2352 x 1568 pixels · FOV: 45 degrees · color fundus image: 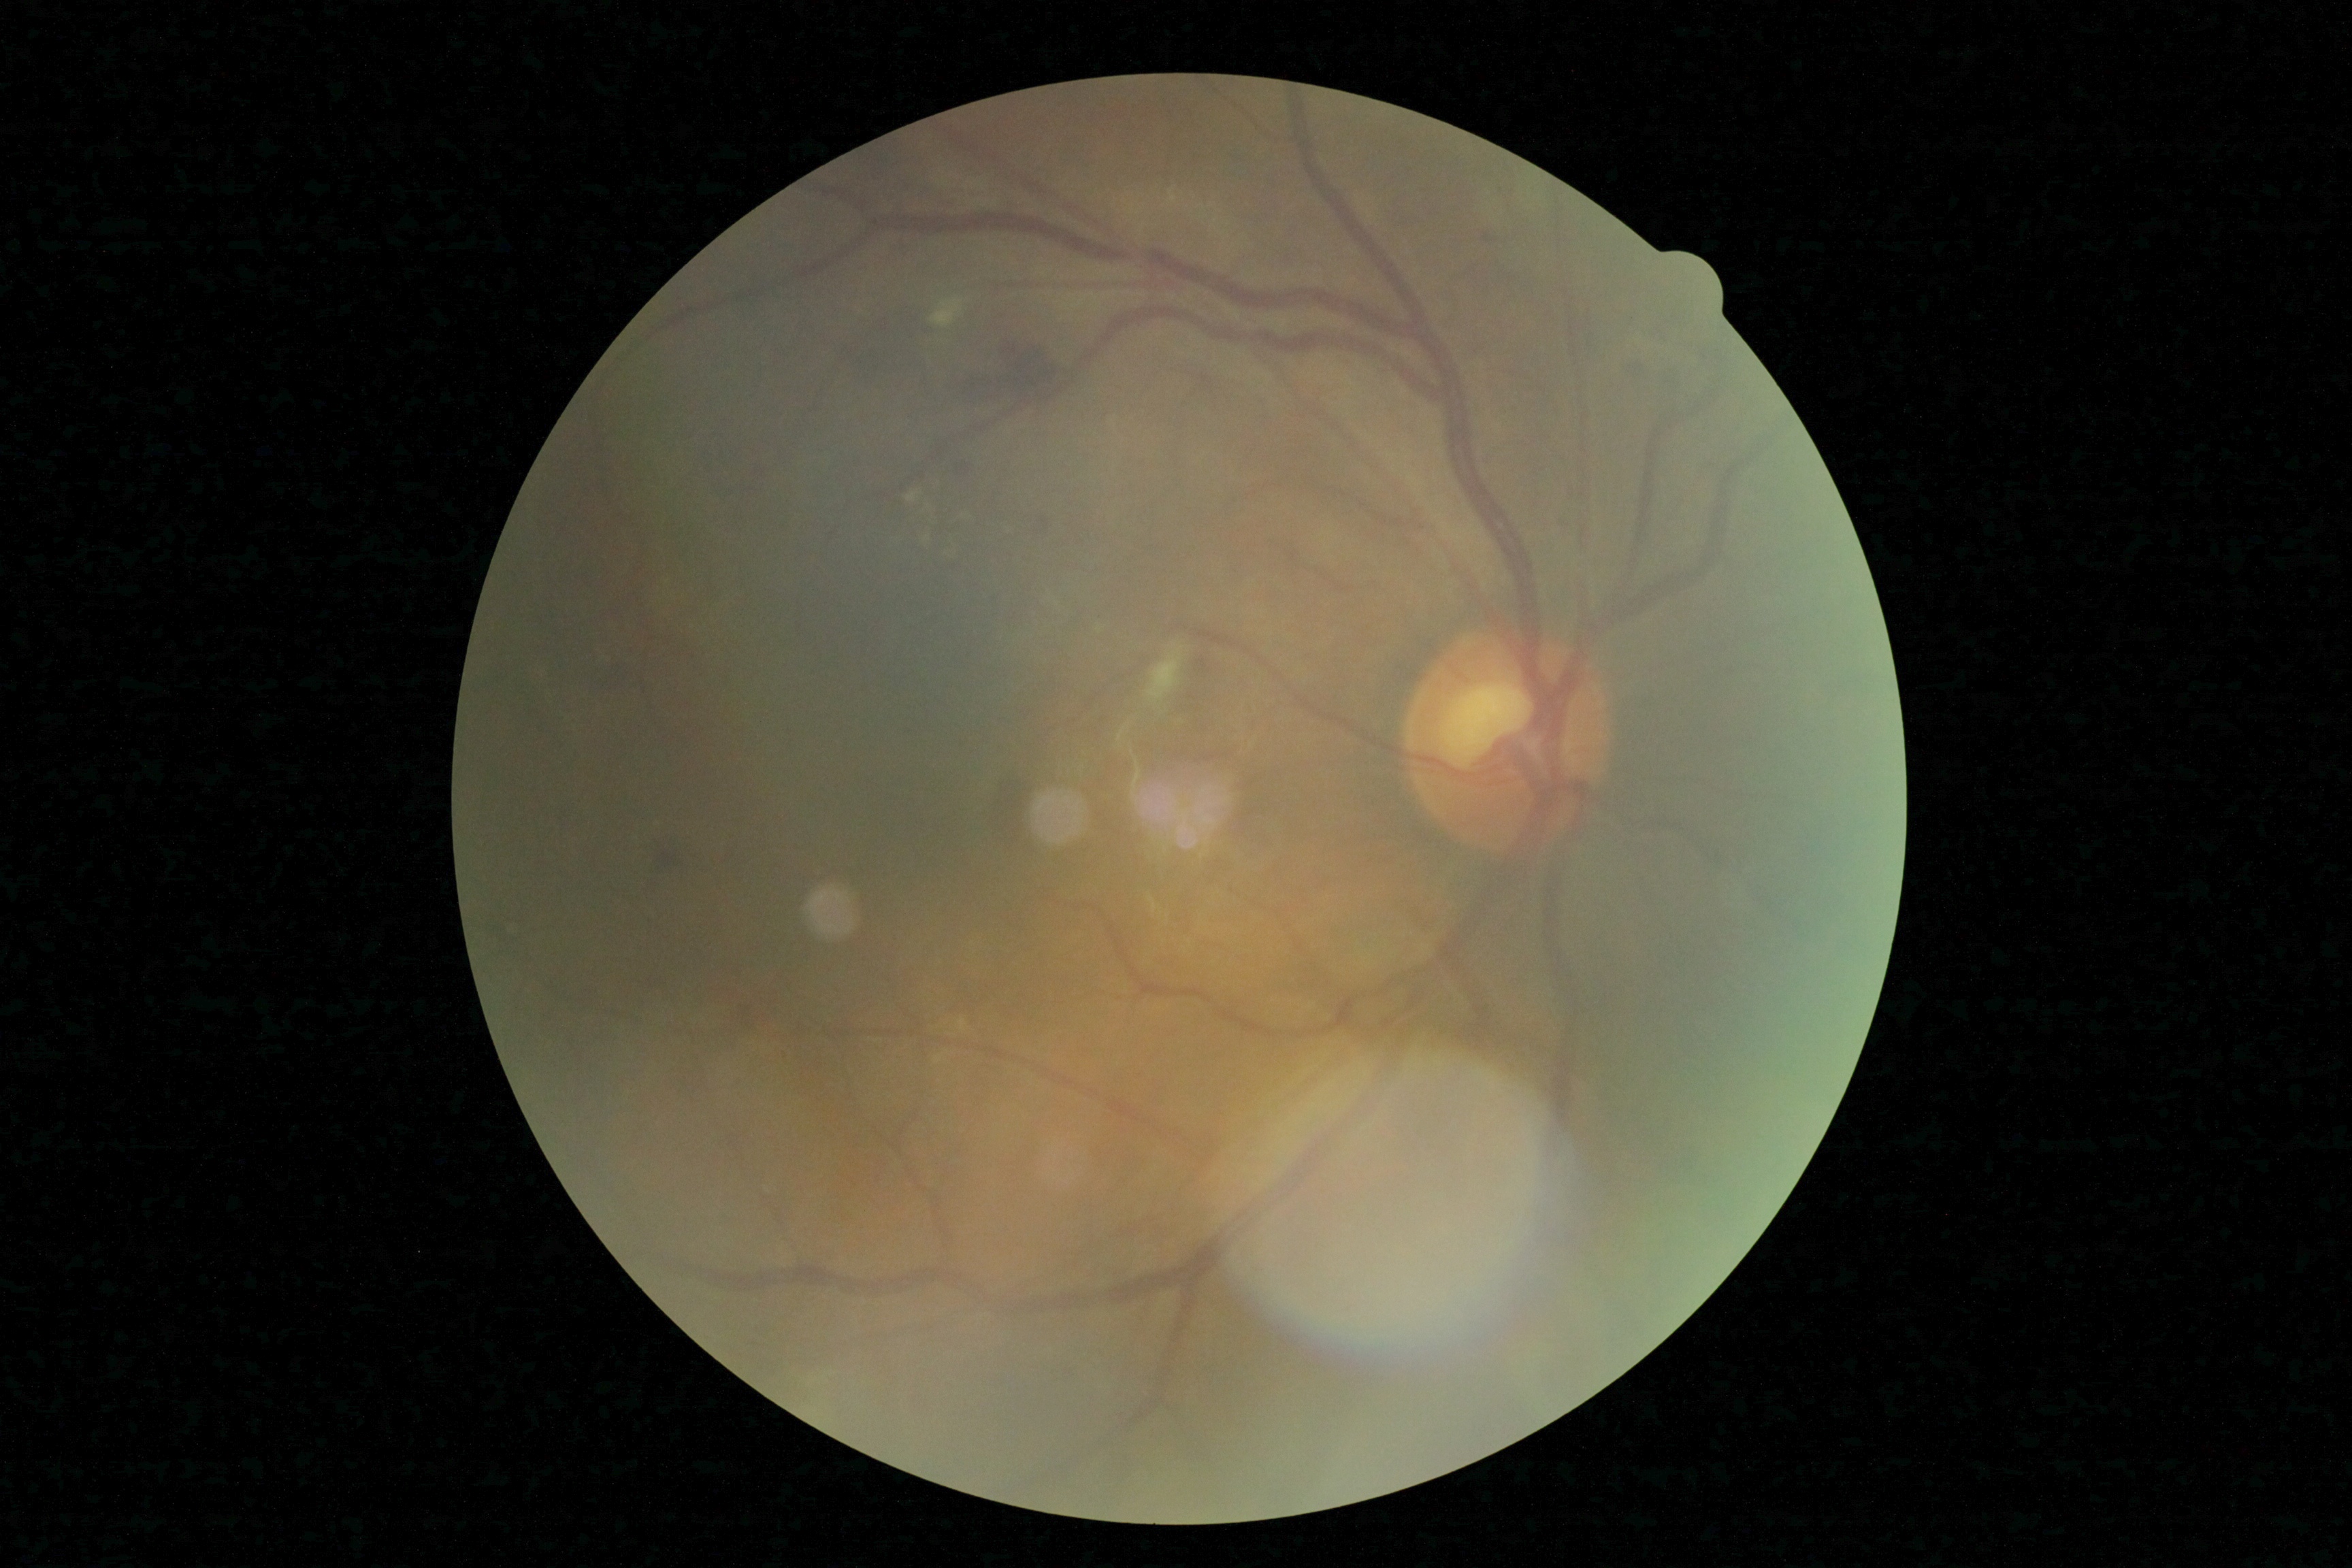 Diabetic retinopathy (DR): 2/4 — more than just microaneurysms but less than severe NPDR.